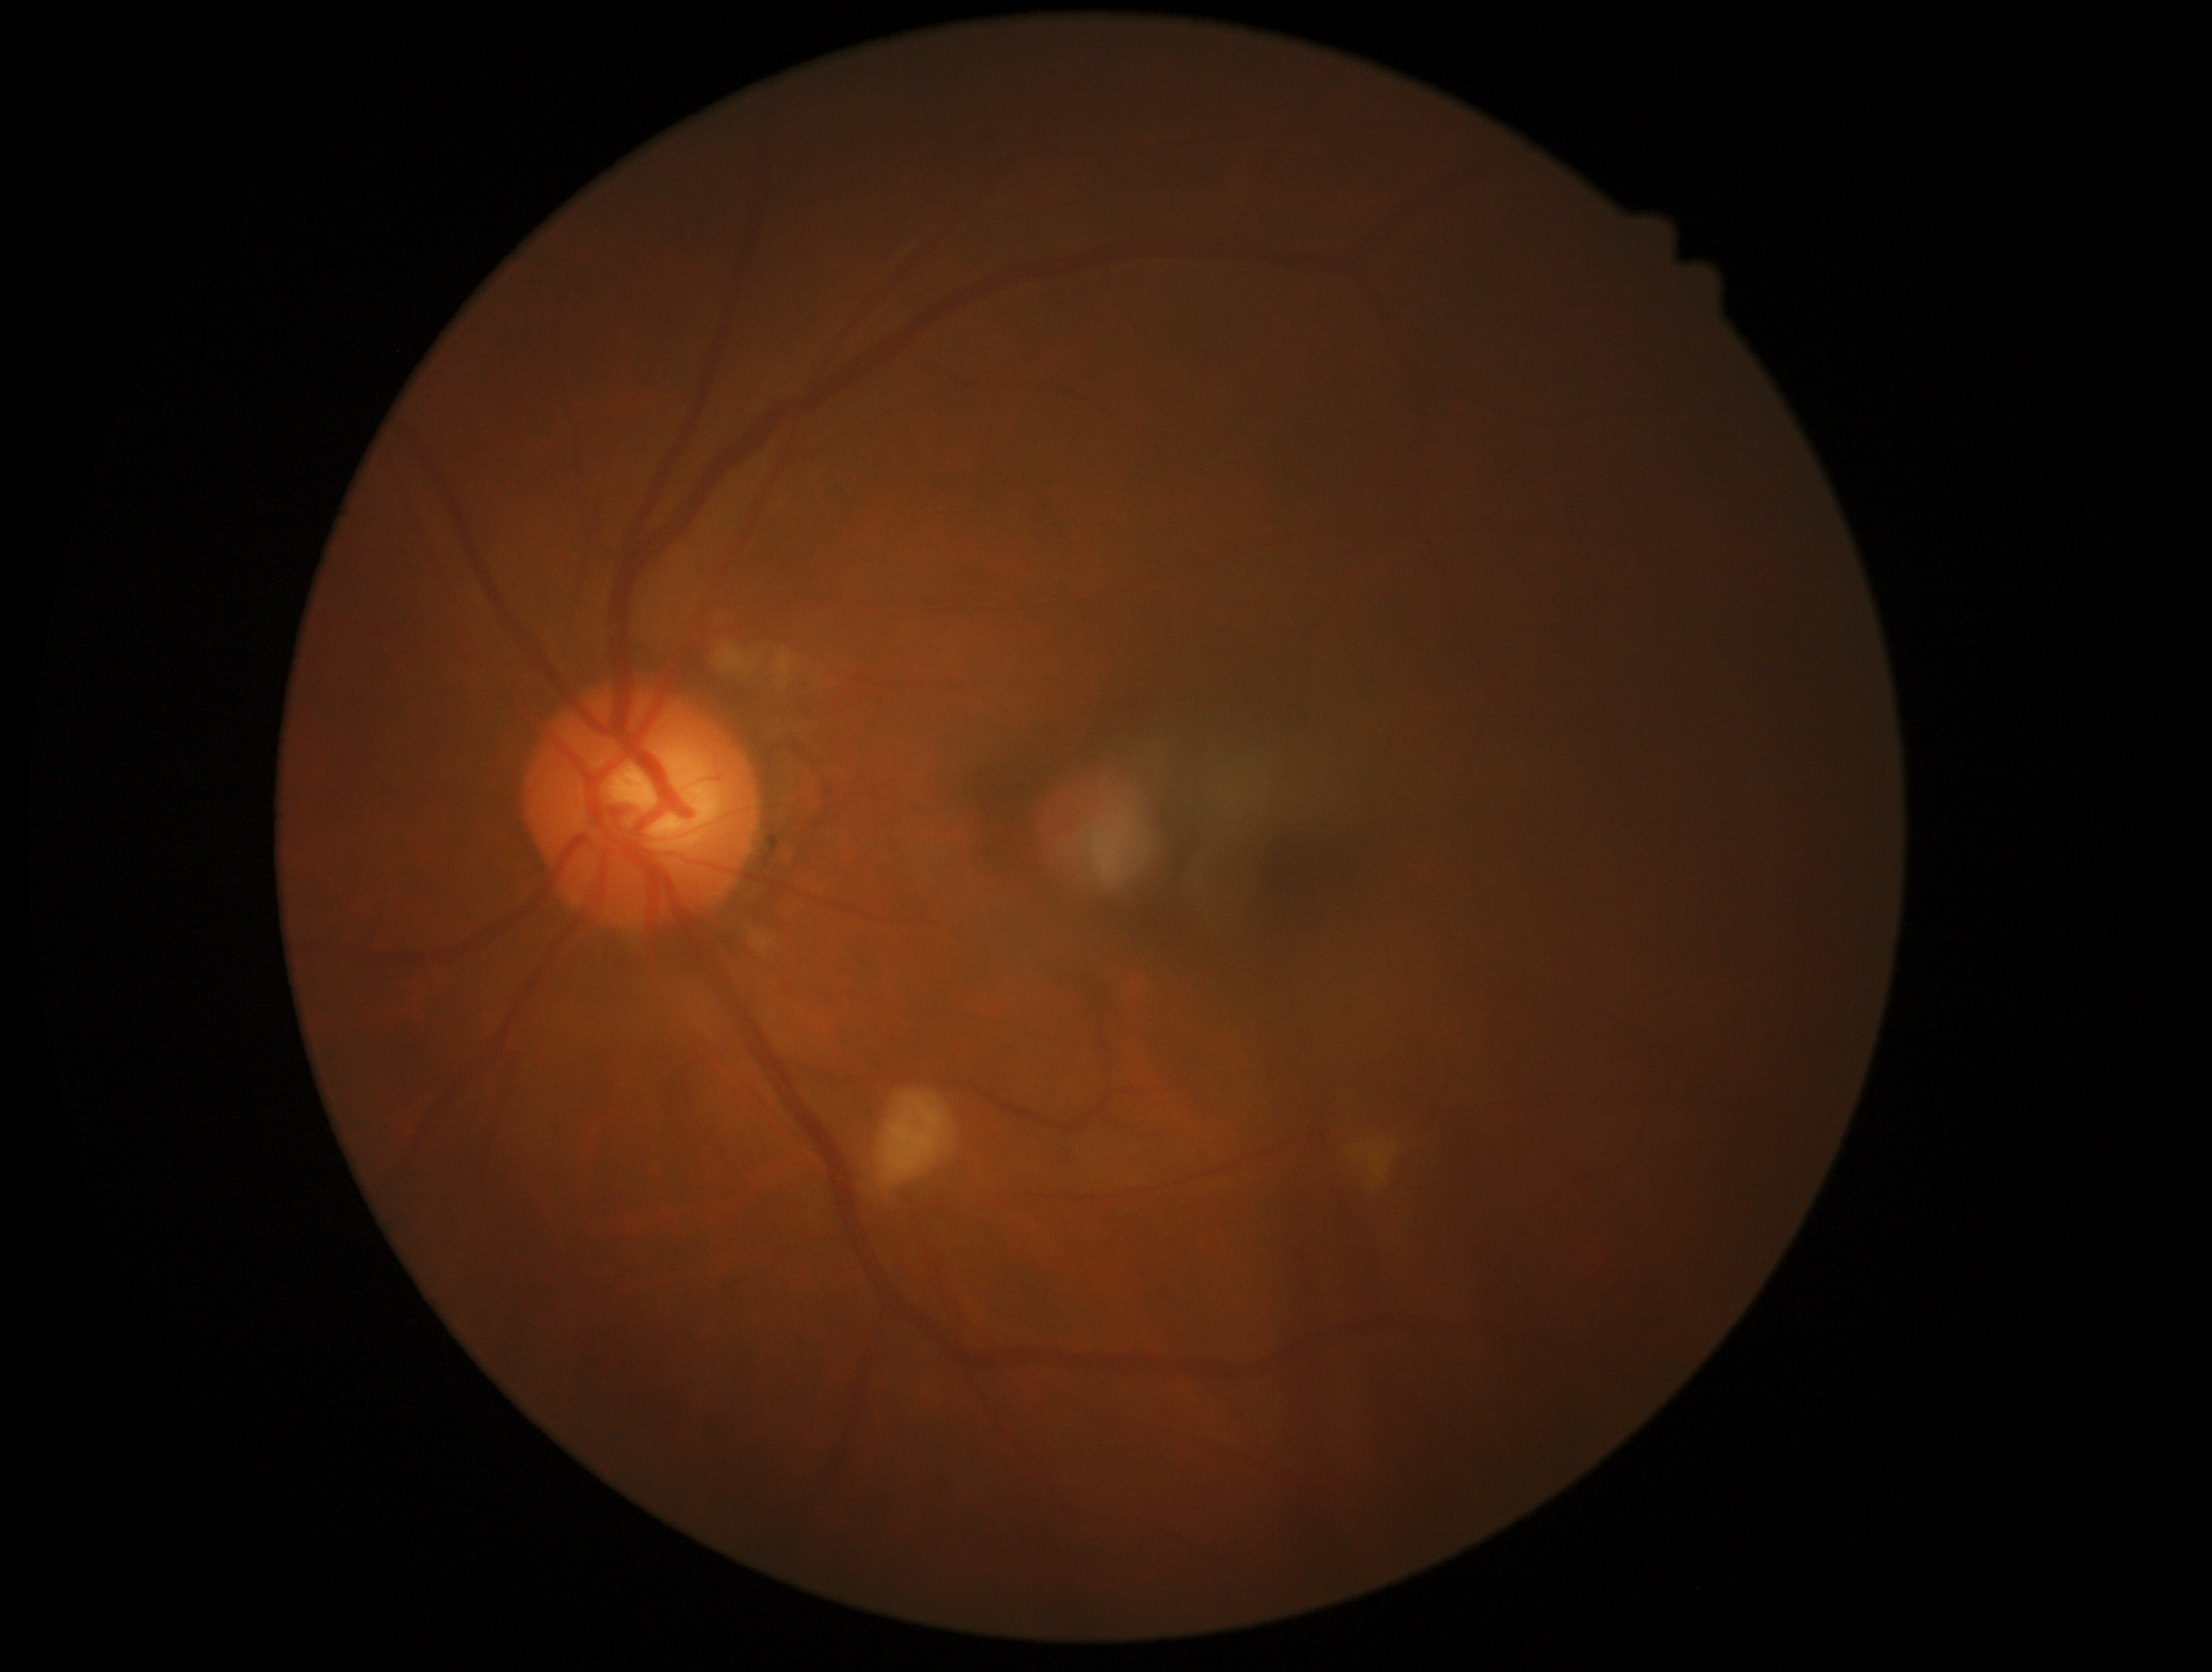

Diabetic retinopathy is grade 2.